Graded on the modified Davis scale.
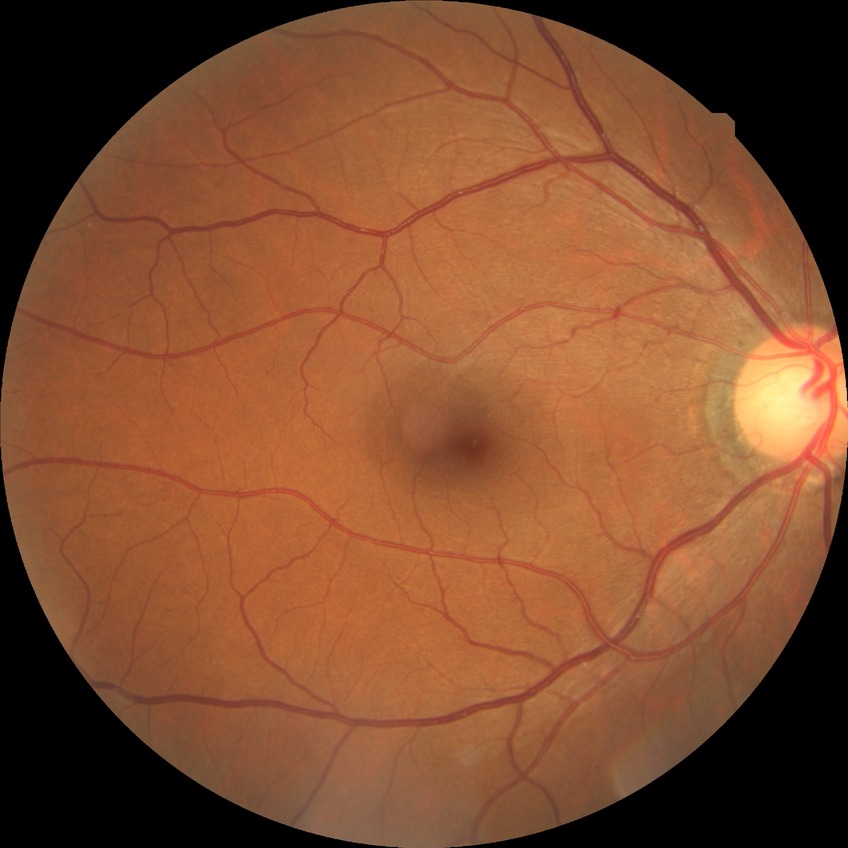 DR impression = no signs of DR | Davis stage = NDR.